NIDEK AFC-230 fundus camera, nonmydriatic, Davis DR grading, FOV: 45 degrees.
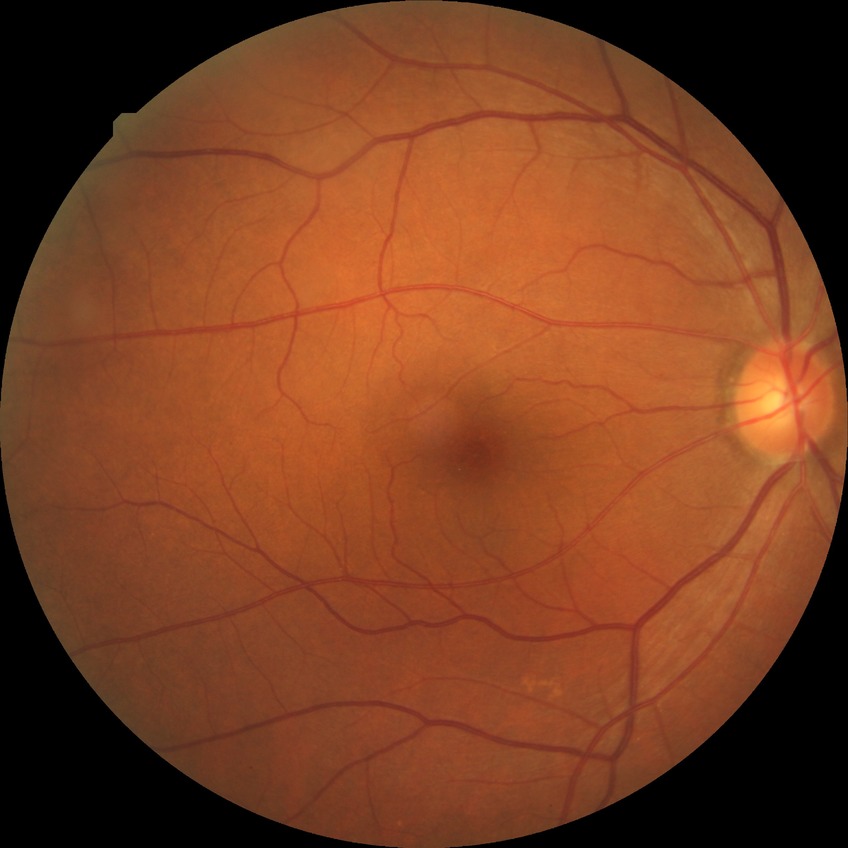 modified Davis classification=pre-proliferative diabetic retinopathy.